Wide-field fundus image from infant ROP screening.
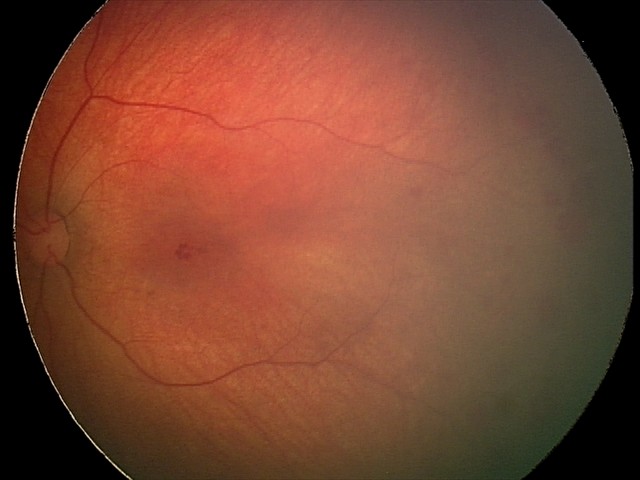 Screening examination consistent with retinal hemorrhages.